Central posterior field
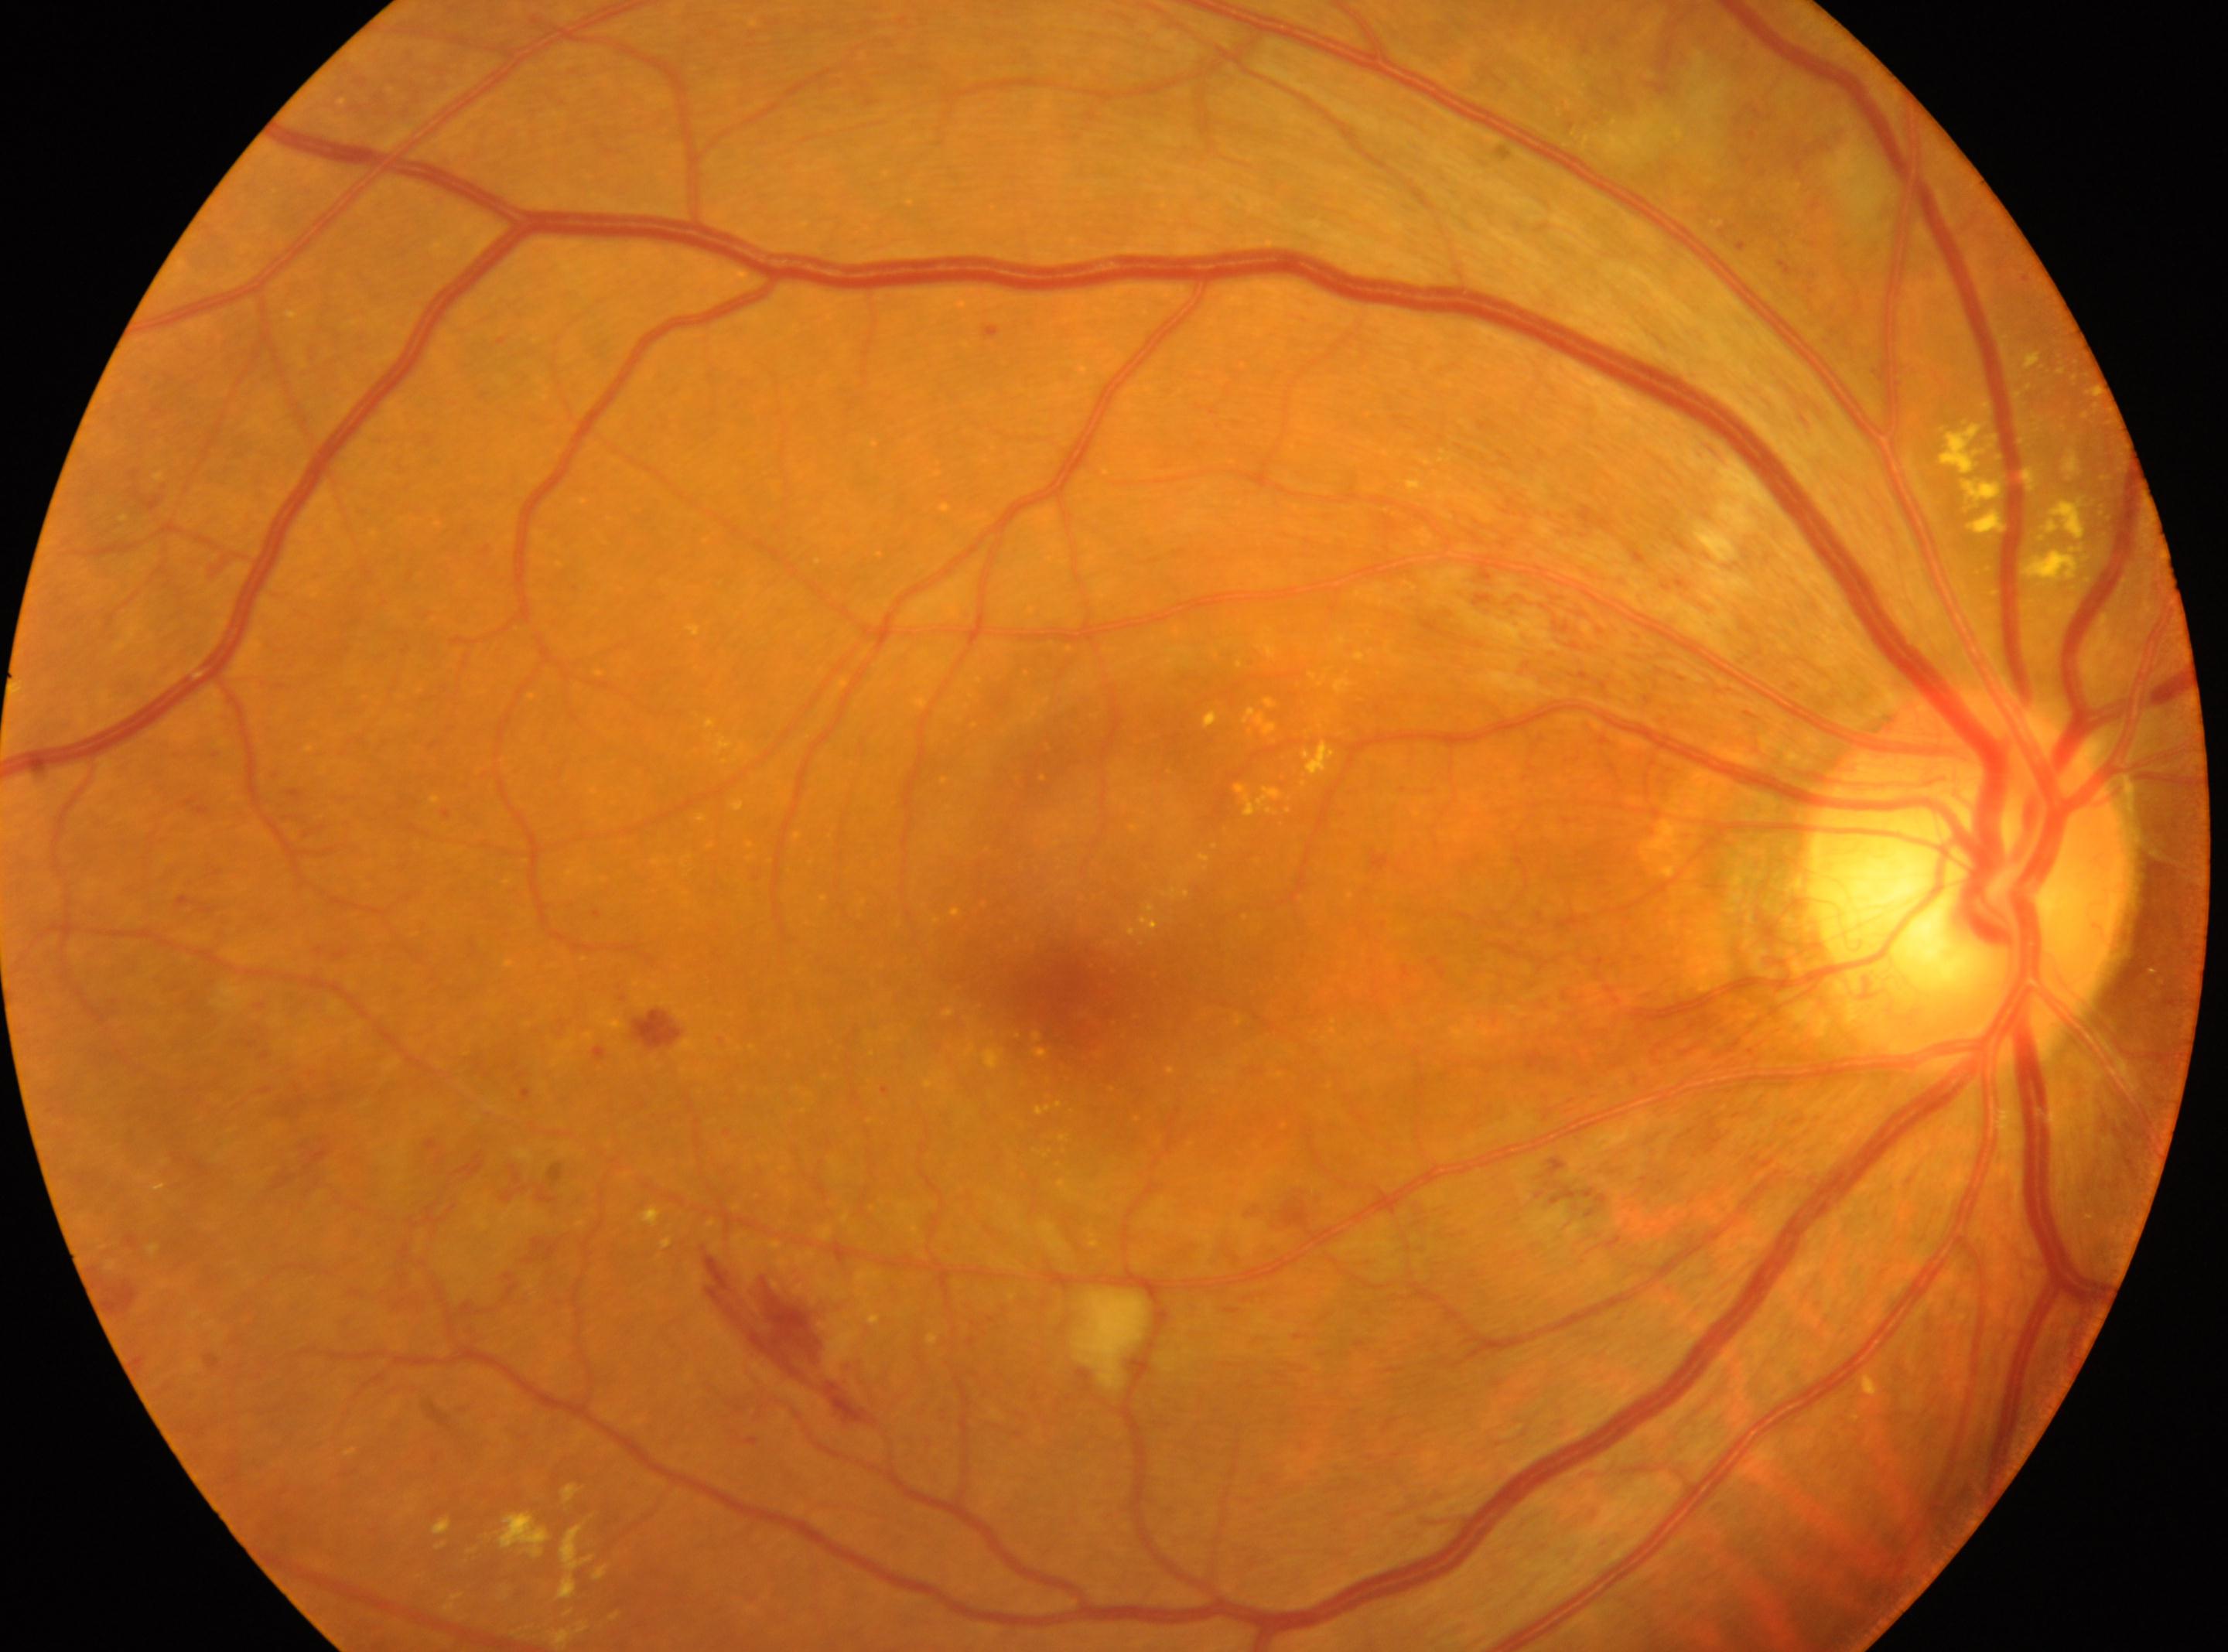

Diabetic retinopathy (DR): grade 2 (moderate NPDR). Eye: right. The retinopathy is classified as non-proliferative diabetic retinopathy. Fovea center located at (1052,985). Optic disc: (1970,882).